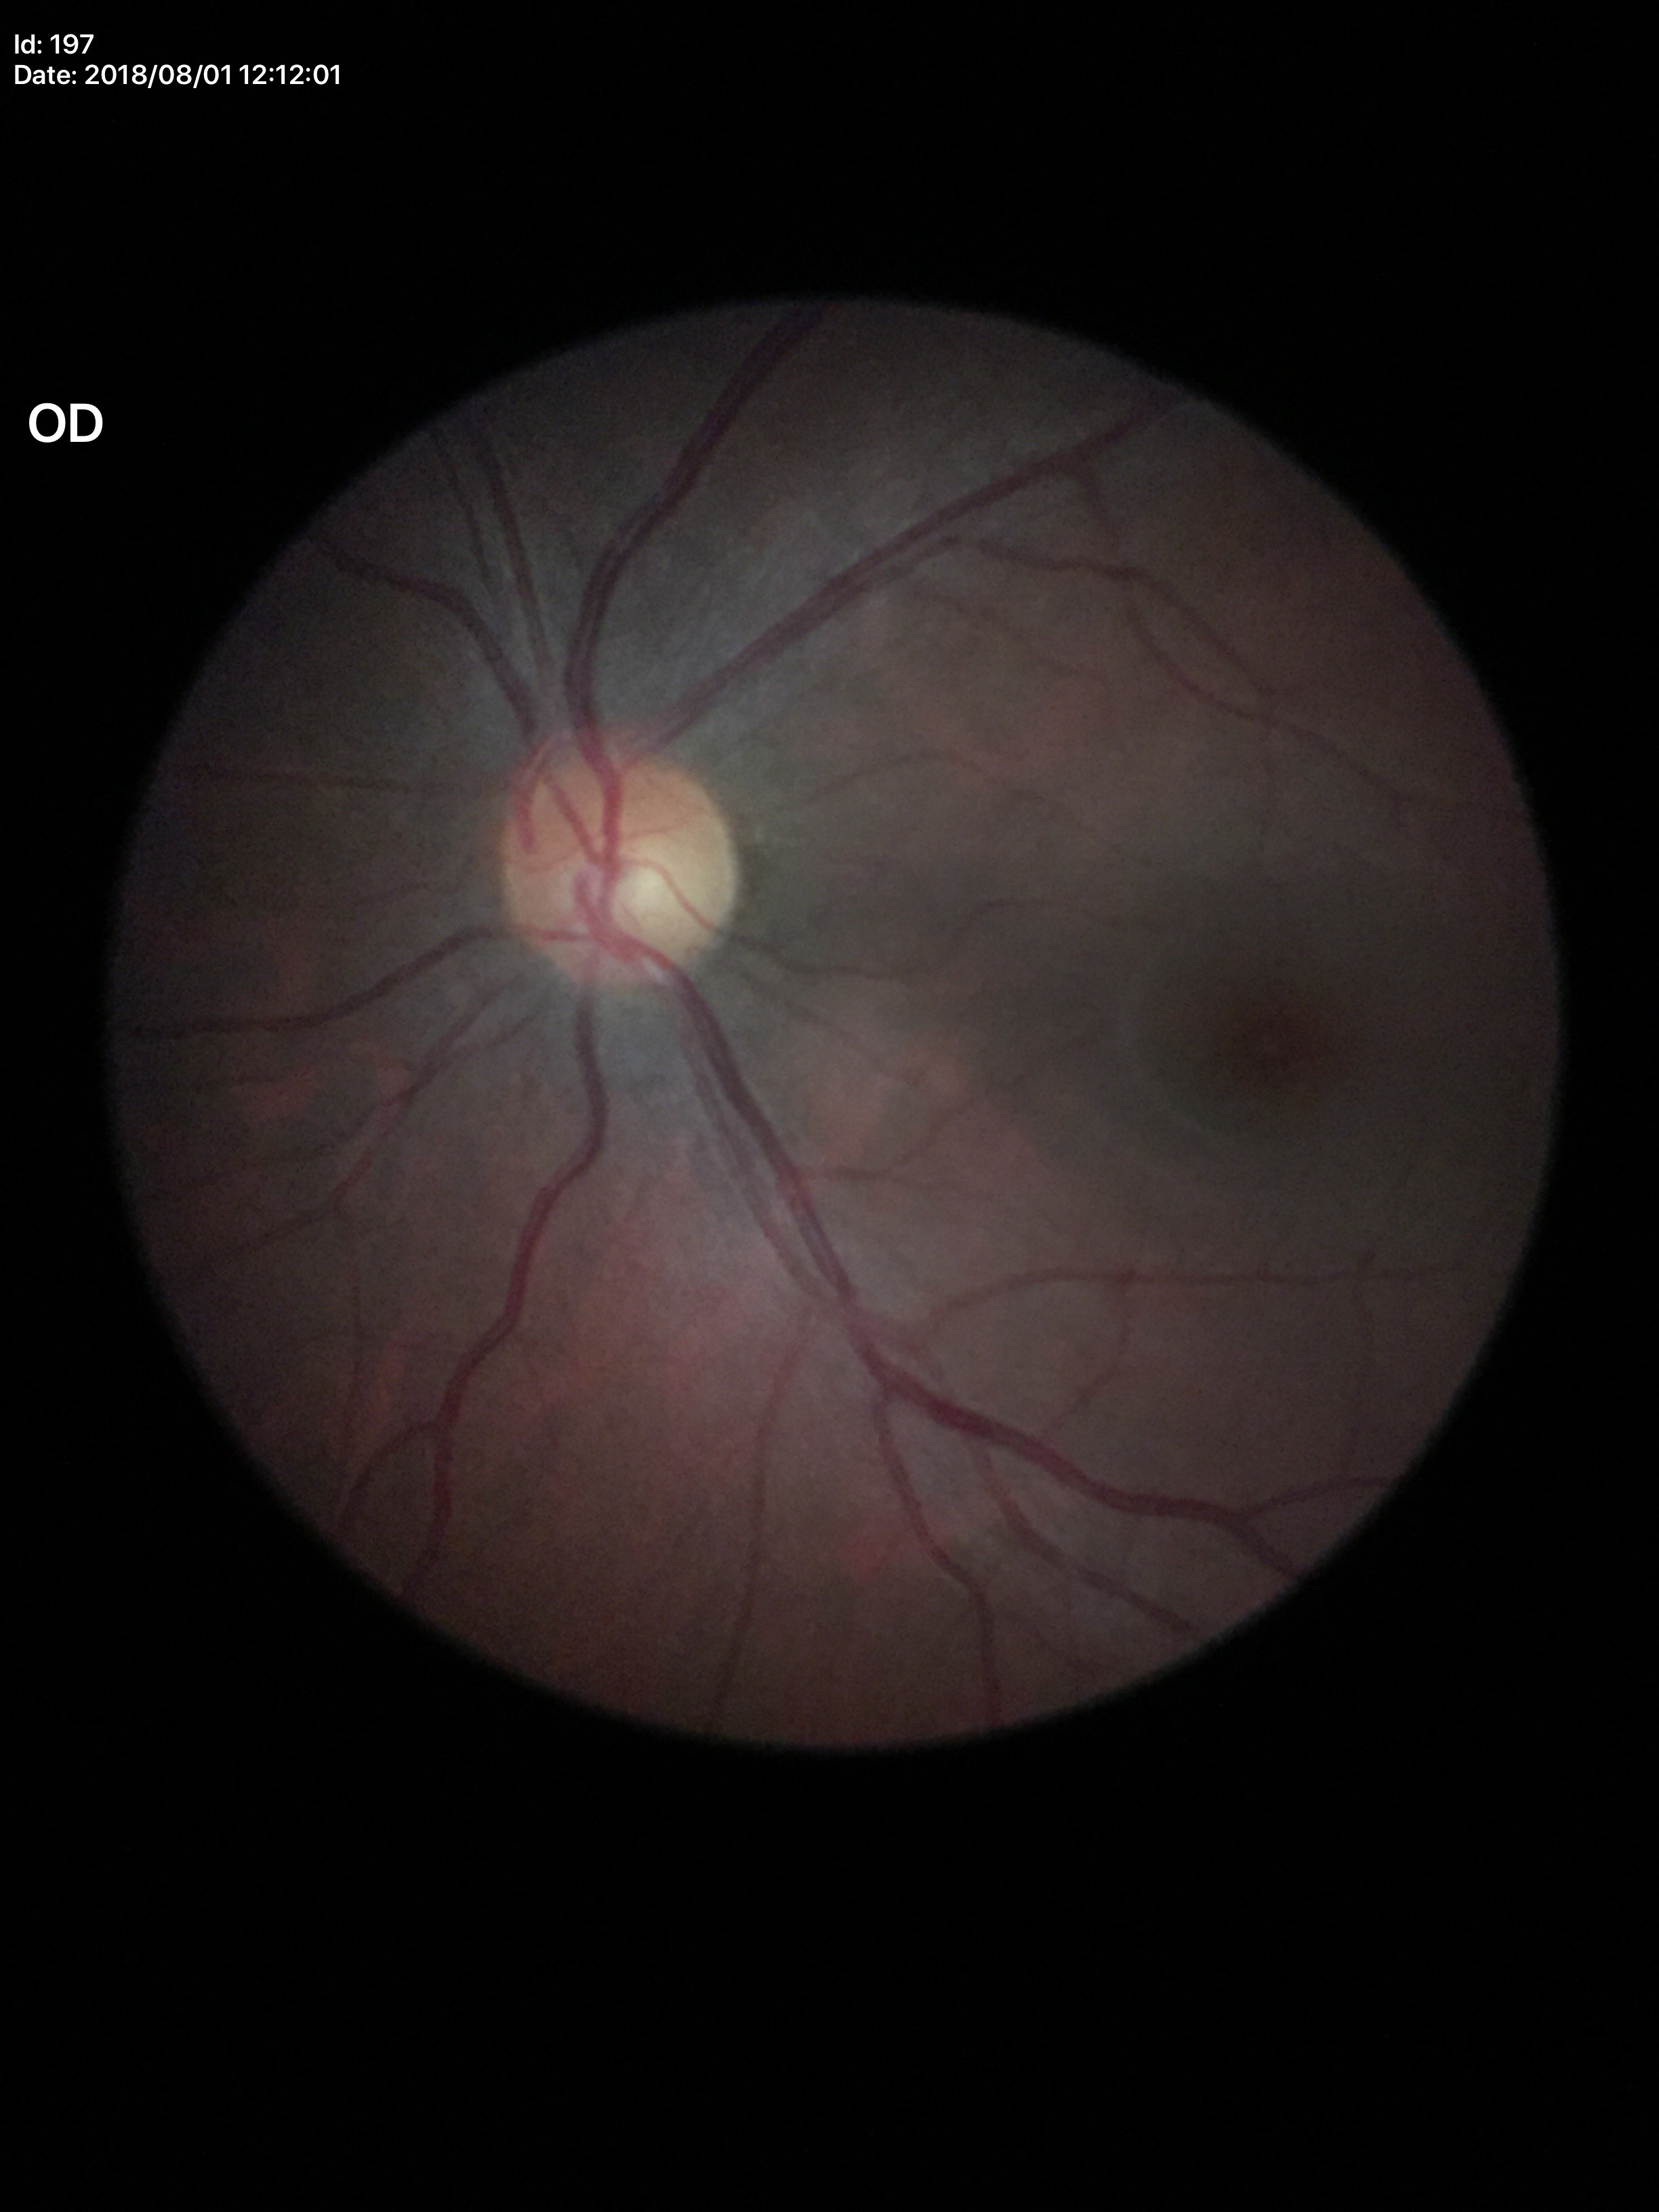
Glaucoma assessment = no suspicious findings (1 of 5 graders flagged glaucoma suspect) | vertical C/D ratio = 0.55 | horizontal CDR = 0.59.